2212 by 1659 pixels: 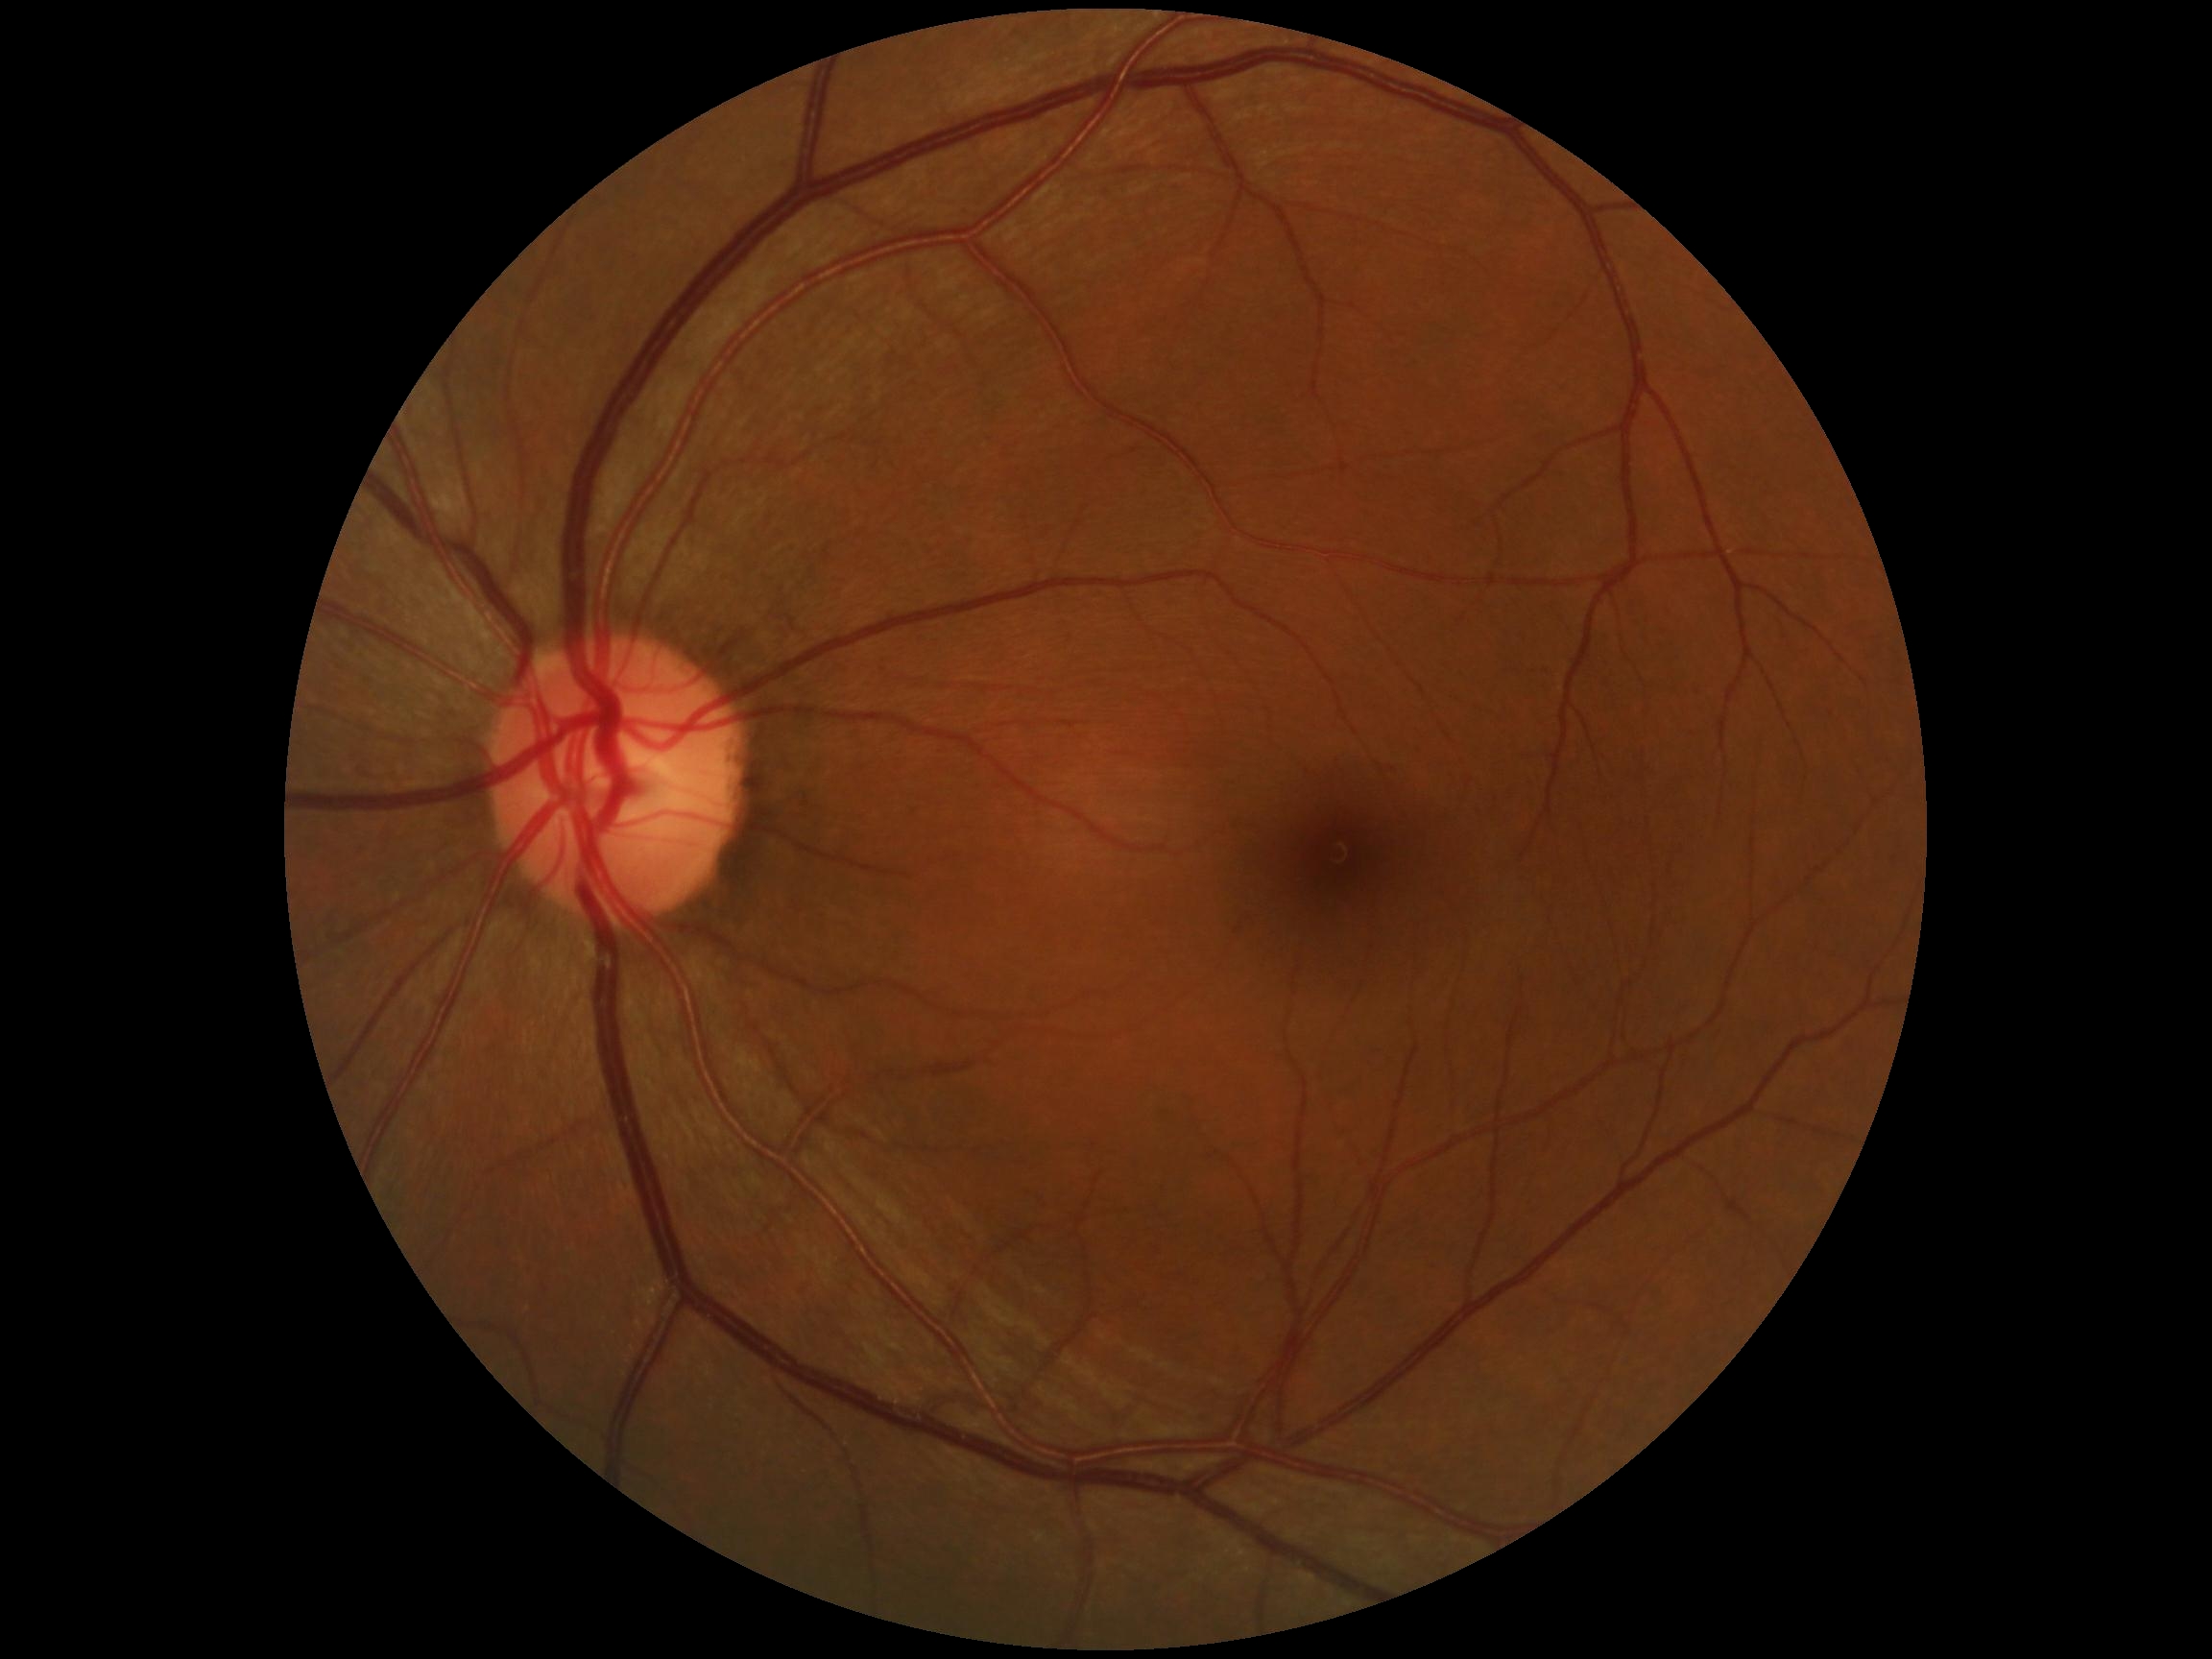 Findings:
- diabetic retinopathy (DR) — 0 — no visible signs of diabetic retinopathy